Fundus photo · FOV: 45 degrees — 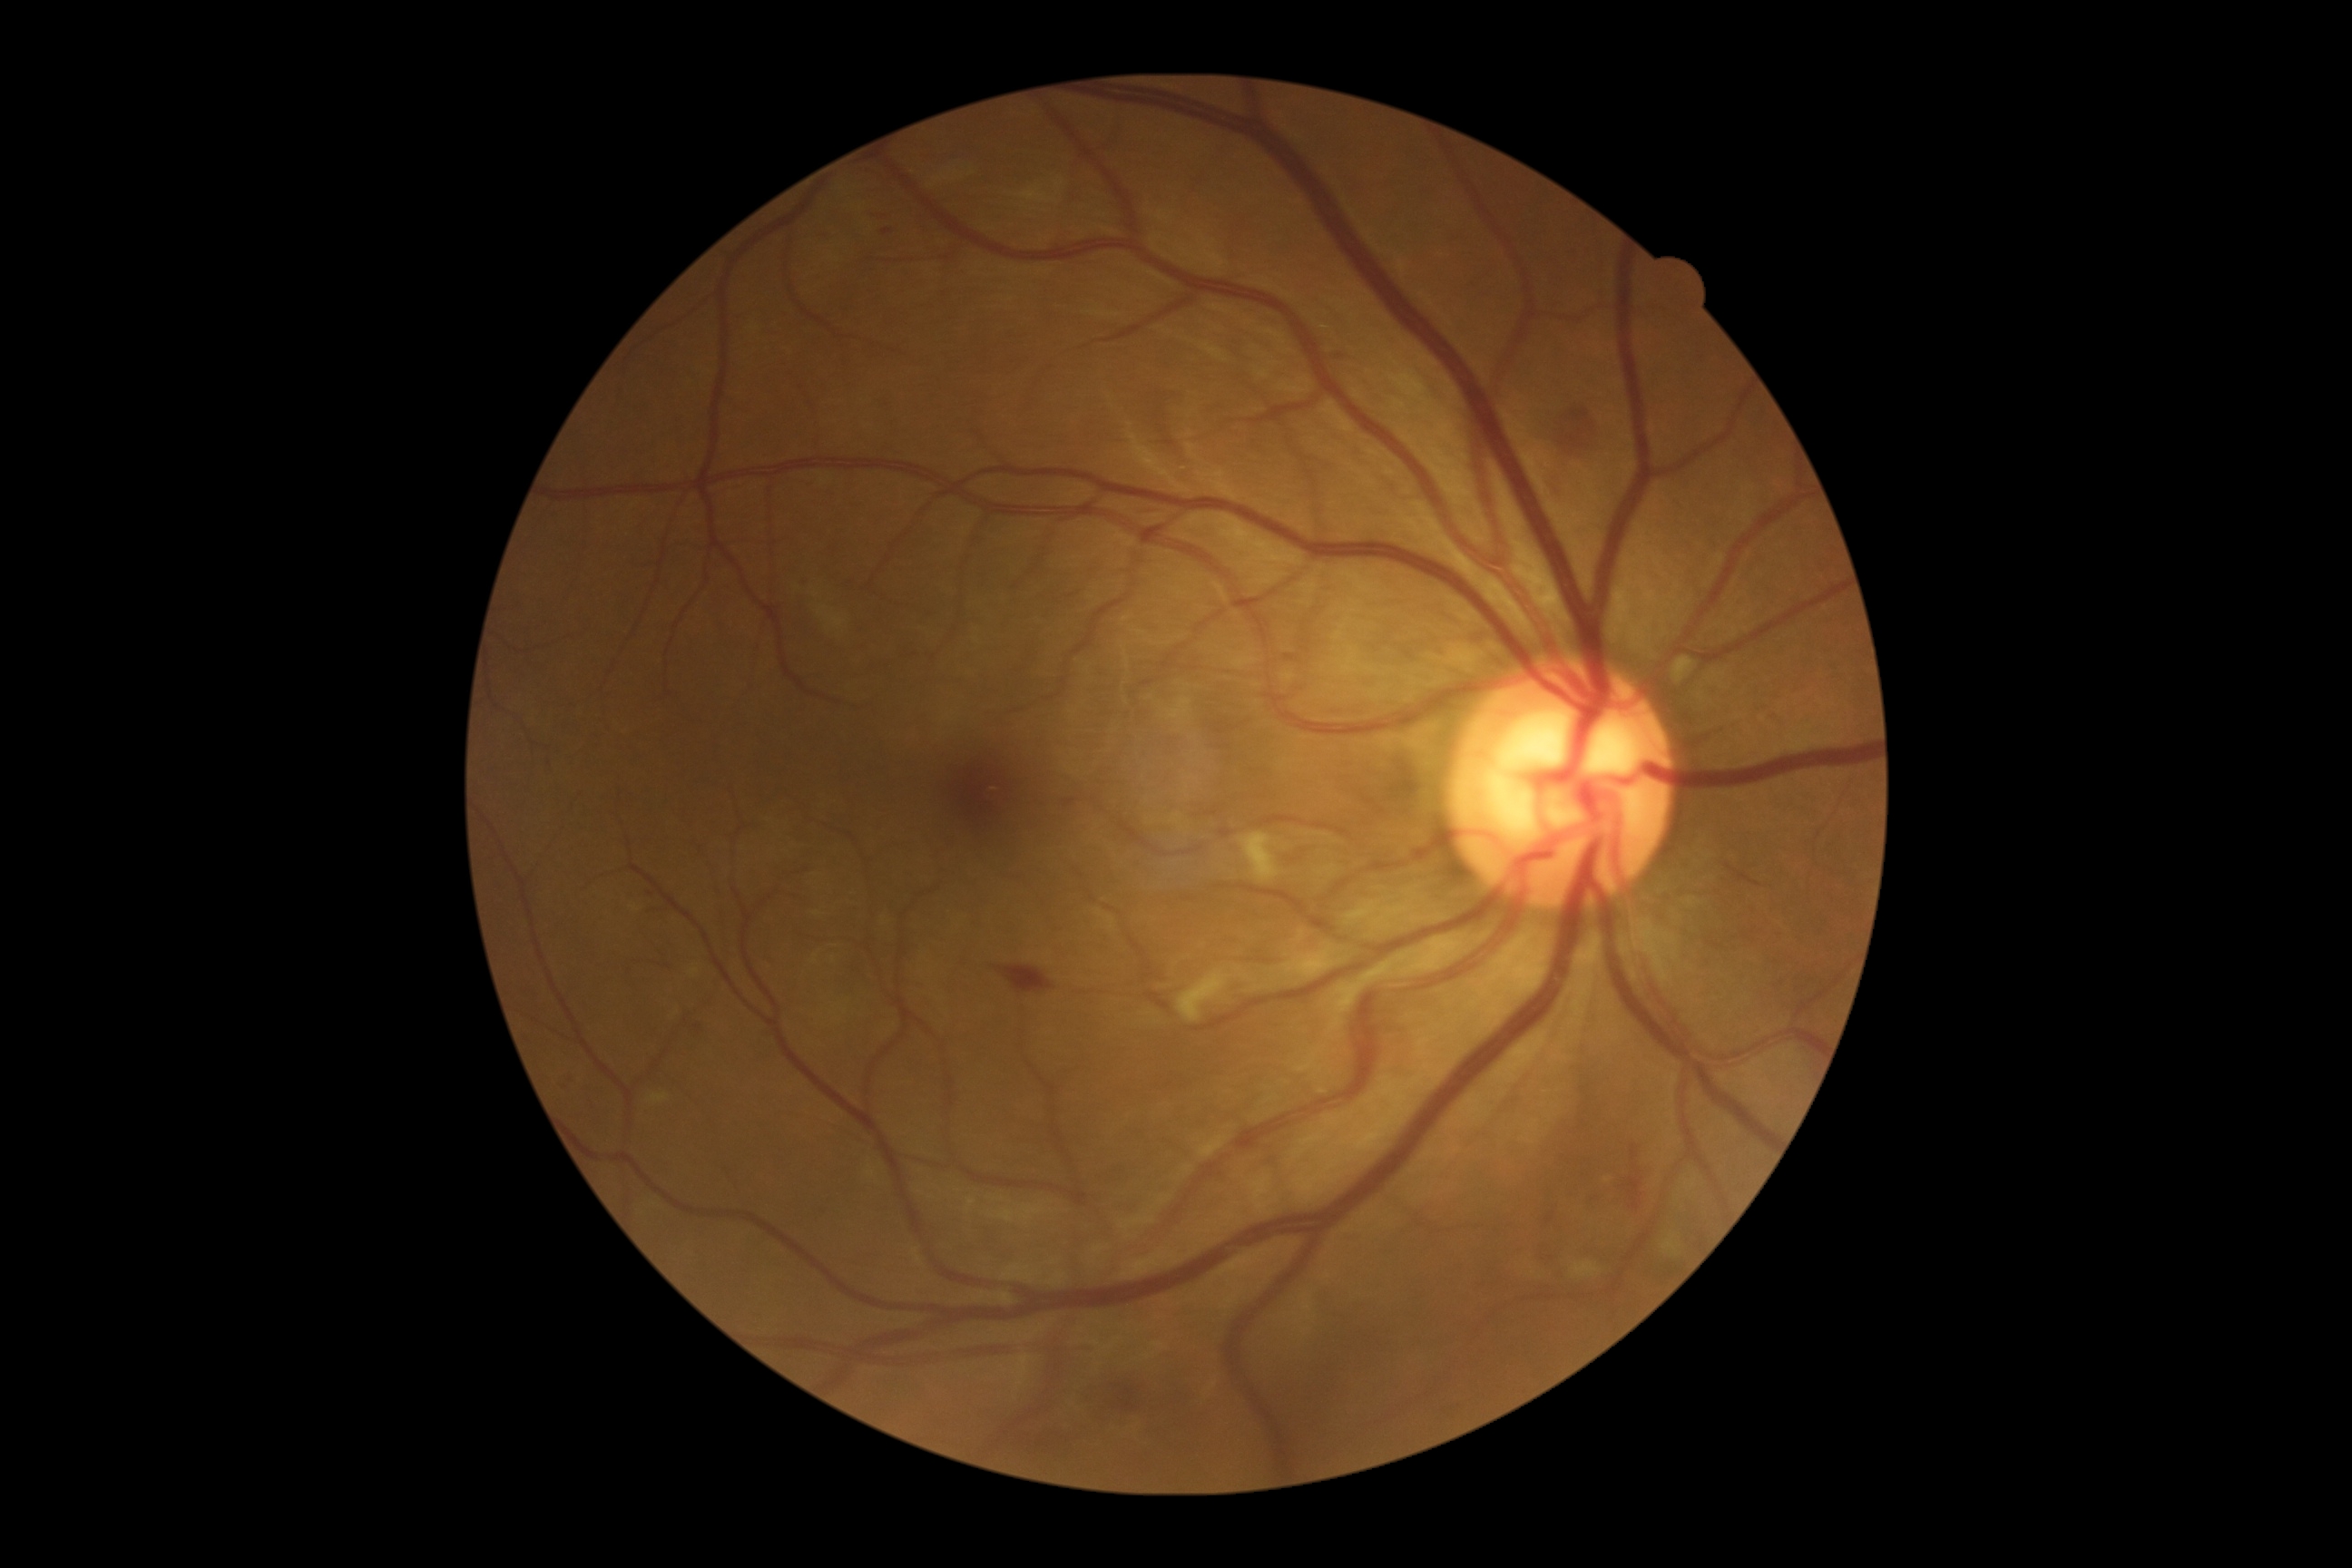 Diabetic retinopathy (DR) is 2/4.